Nonmydriatic
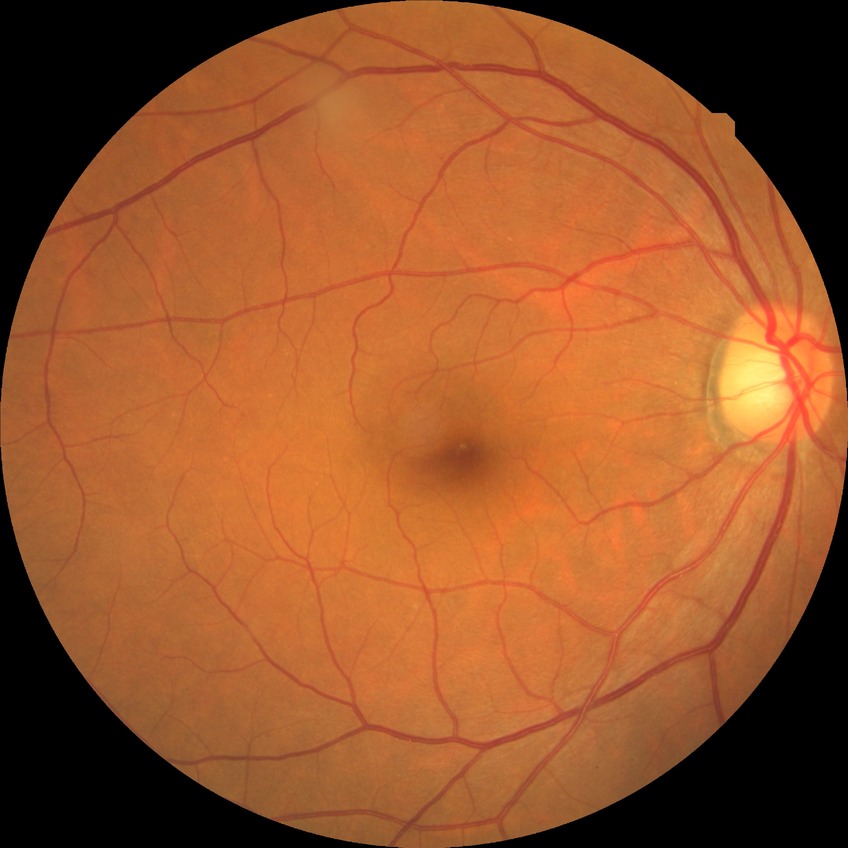
DR impression=no apparent DR, DR stage=NDR.